240 by 240 pixels · fundus photo: 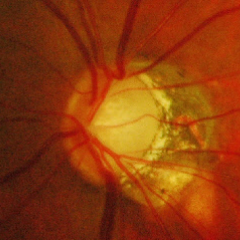 Glaucomatous optic neuropathy is present. Glaucoma assessment = advanced glaucoma.